Color fundus photograph · 512 x 512 pixels:
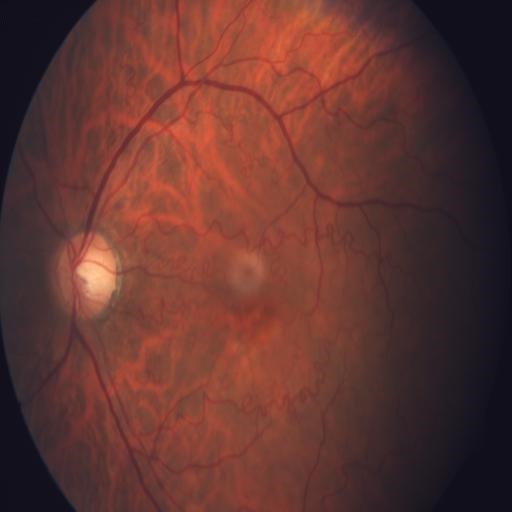 Demonstrates optic disc pallor and tortuous vessels.